Wide-field contact fundus photograph of an infant — 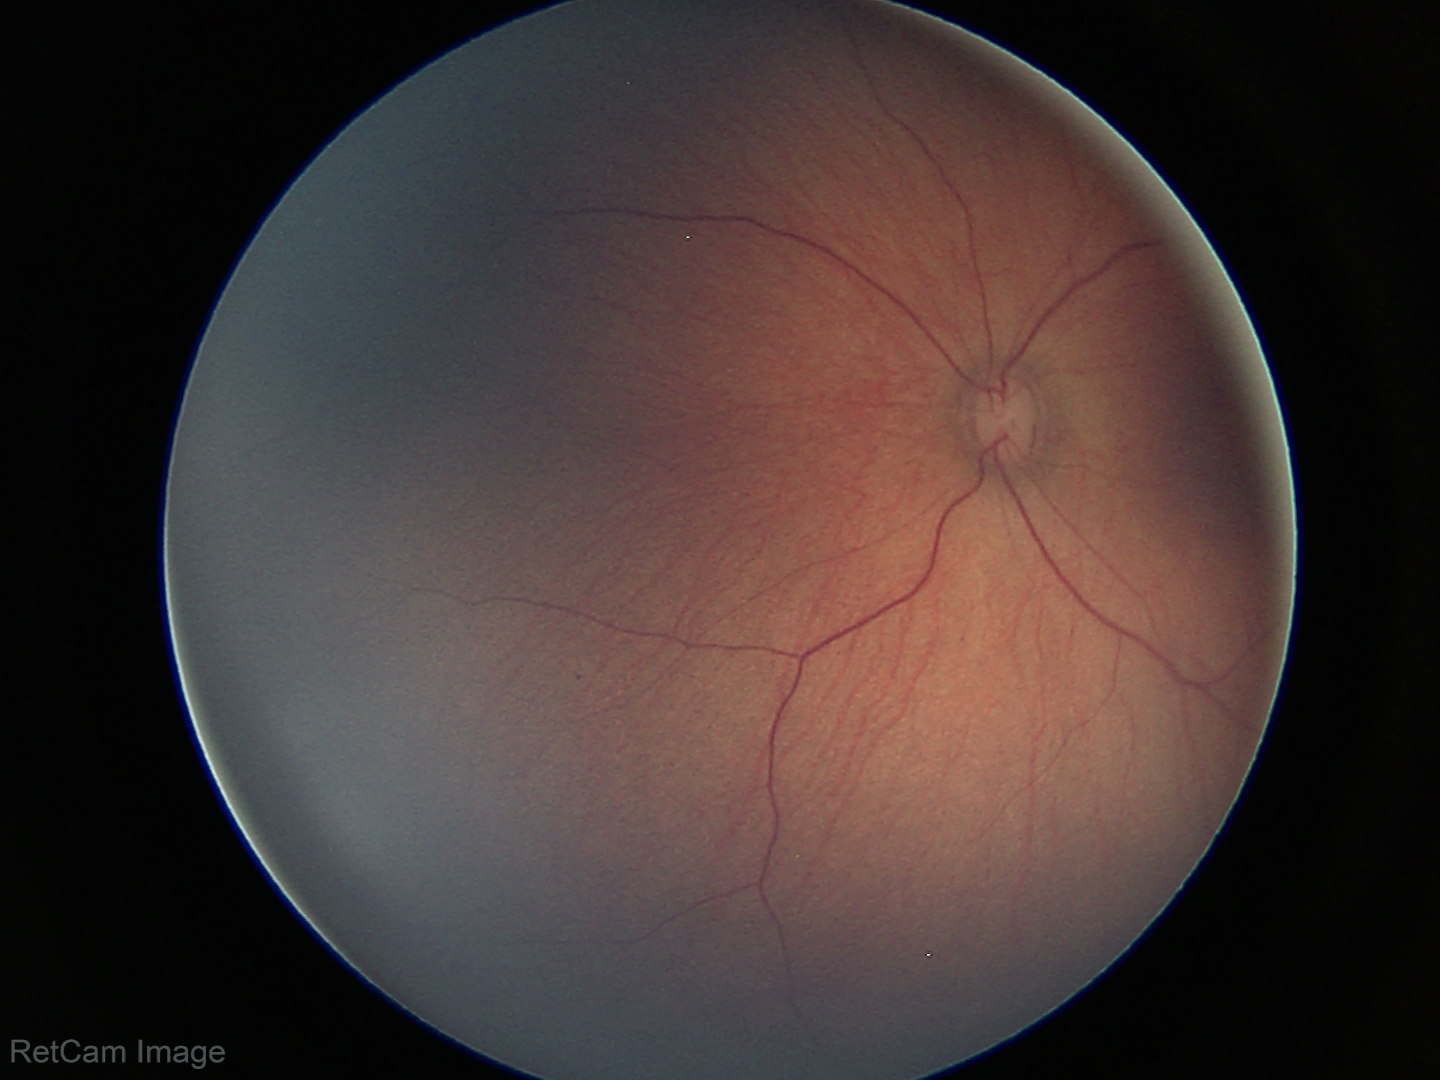

Finding = physiological appearance.